Diabetic retinopathy graded by the modified Davis classification.
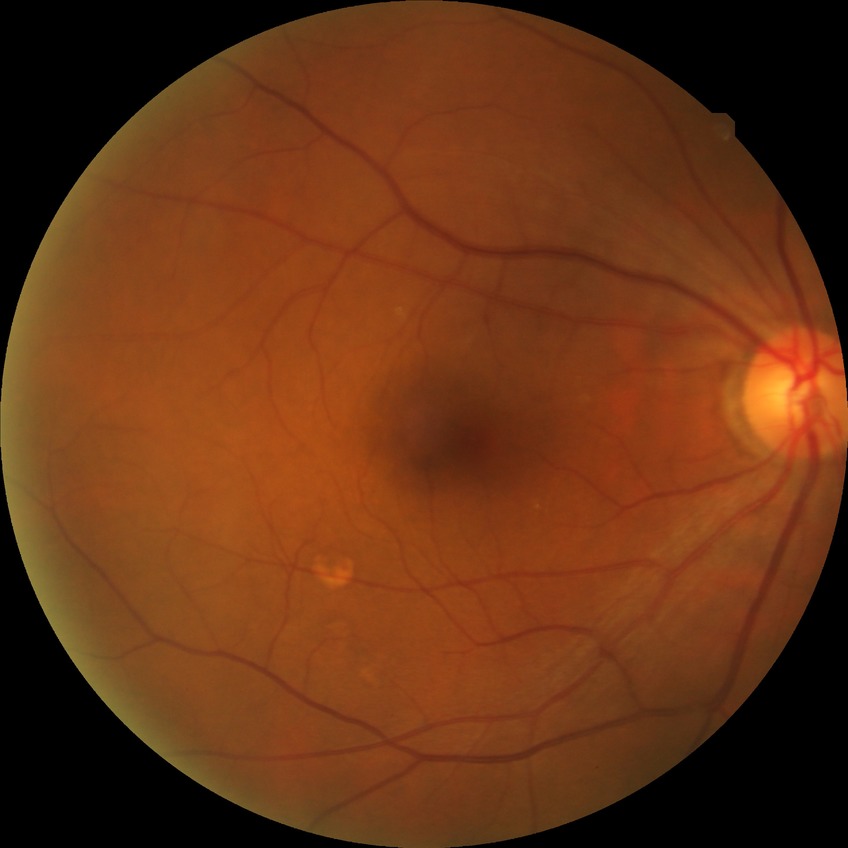 modified Davis classification = no diabetic retinopathy.